Wide-field fundus image from infant ROP screening; acquired on the Clarity RetCam 3:
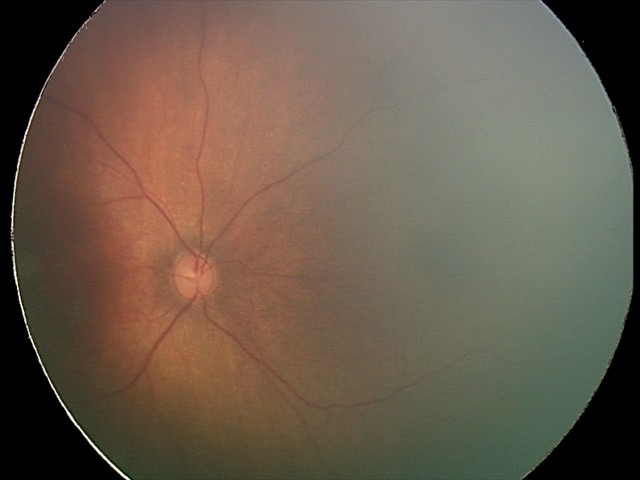

Q: What is the screening diagnosis?
A: normal retinal appearance